NIDEK AFC-230 · 848 x 848 pixels · FOV: 45 degrees.
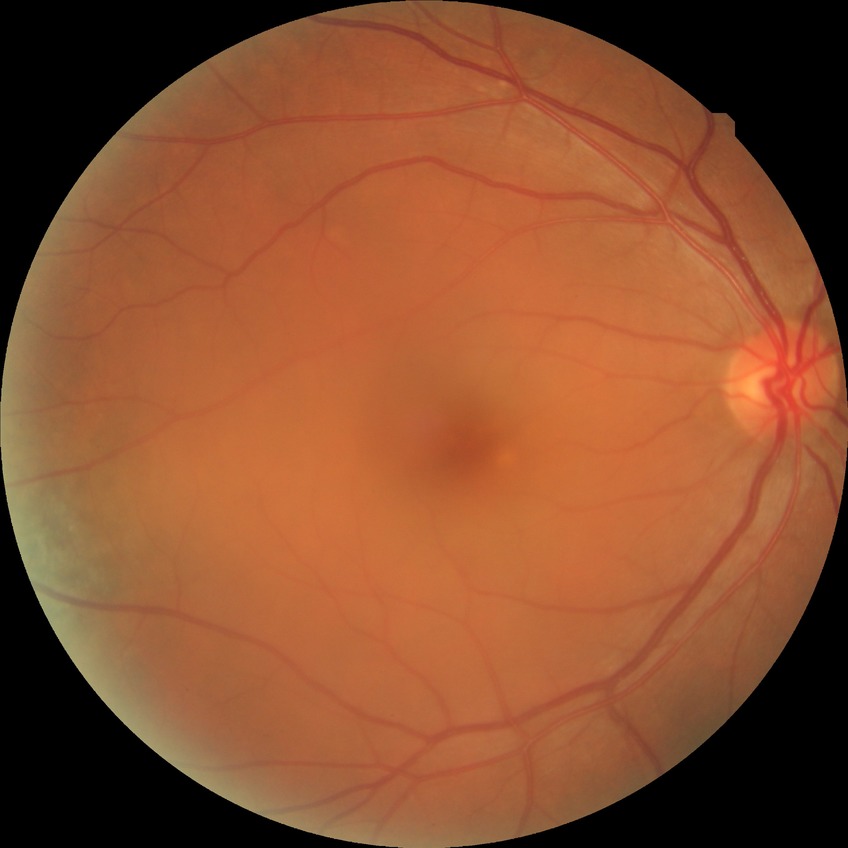   davis_grade: no diabetic retinopathy